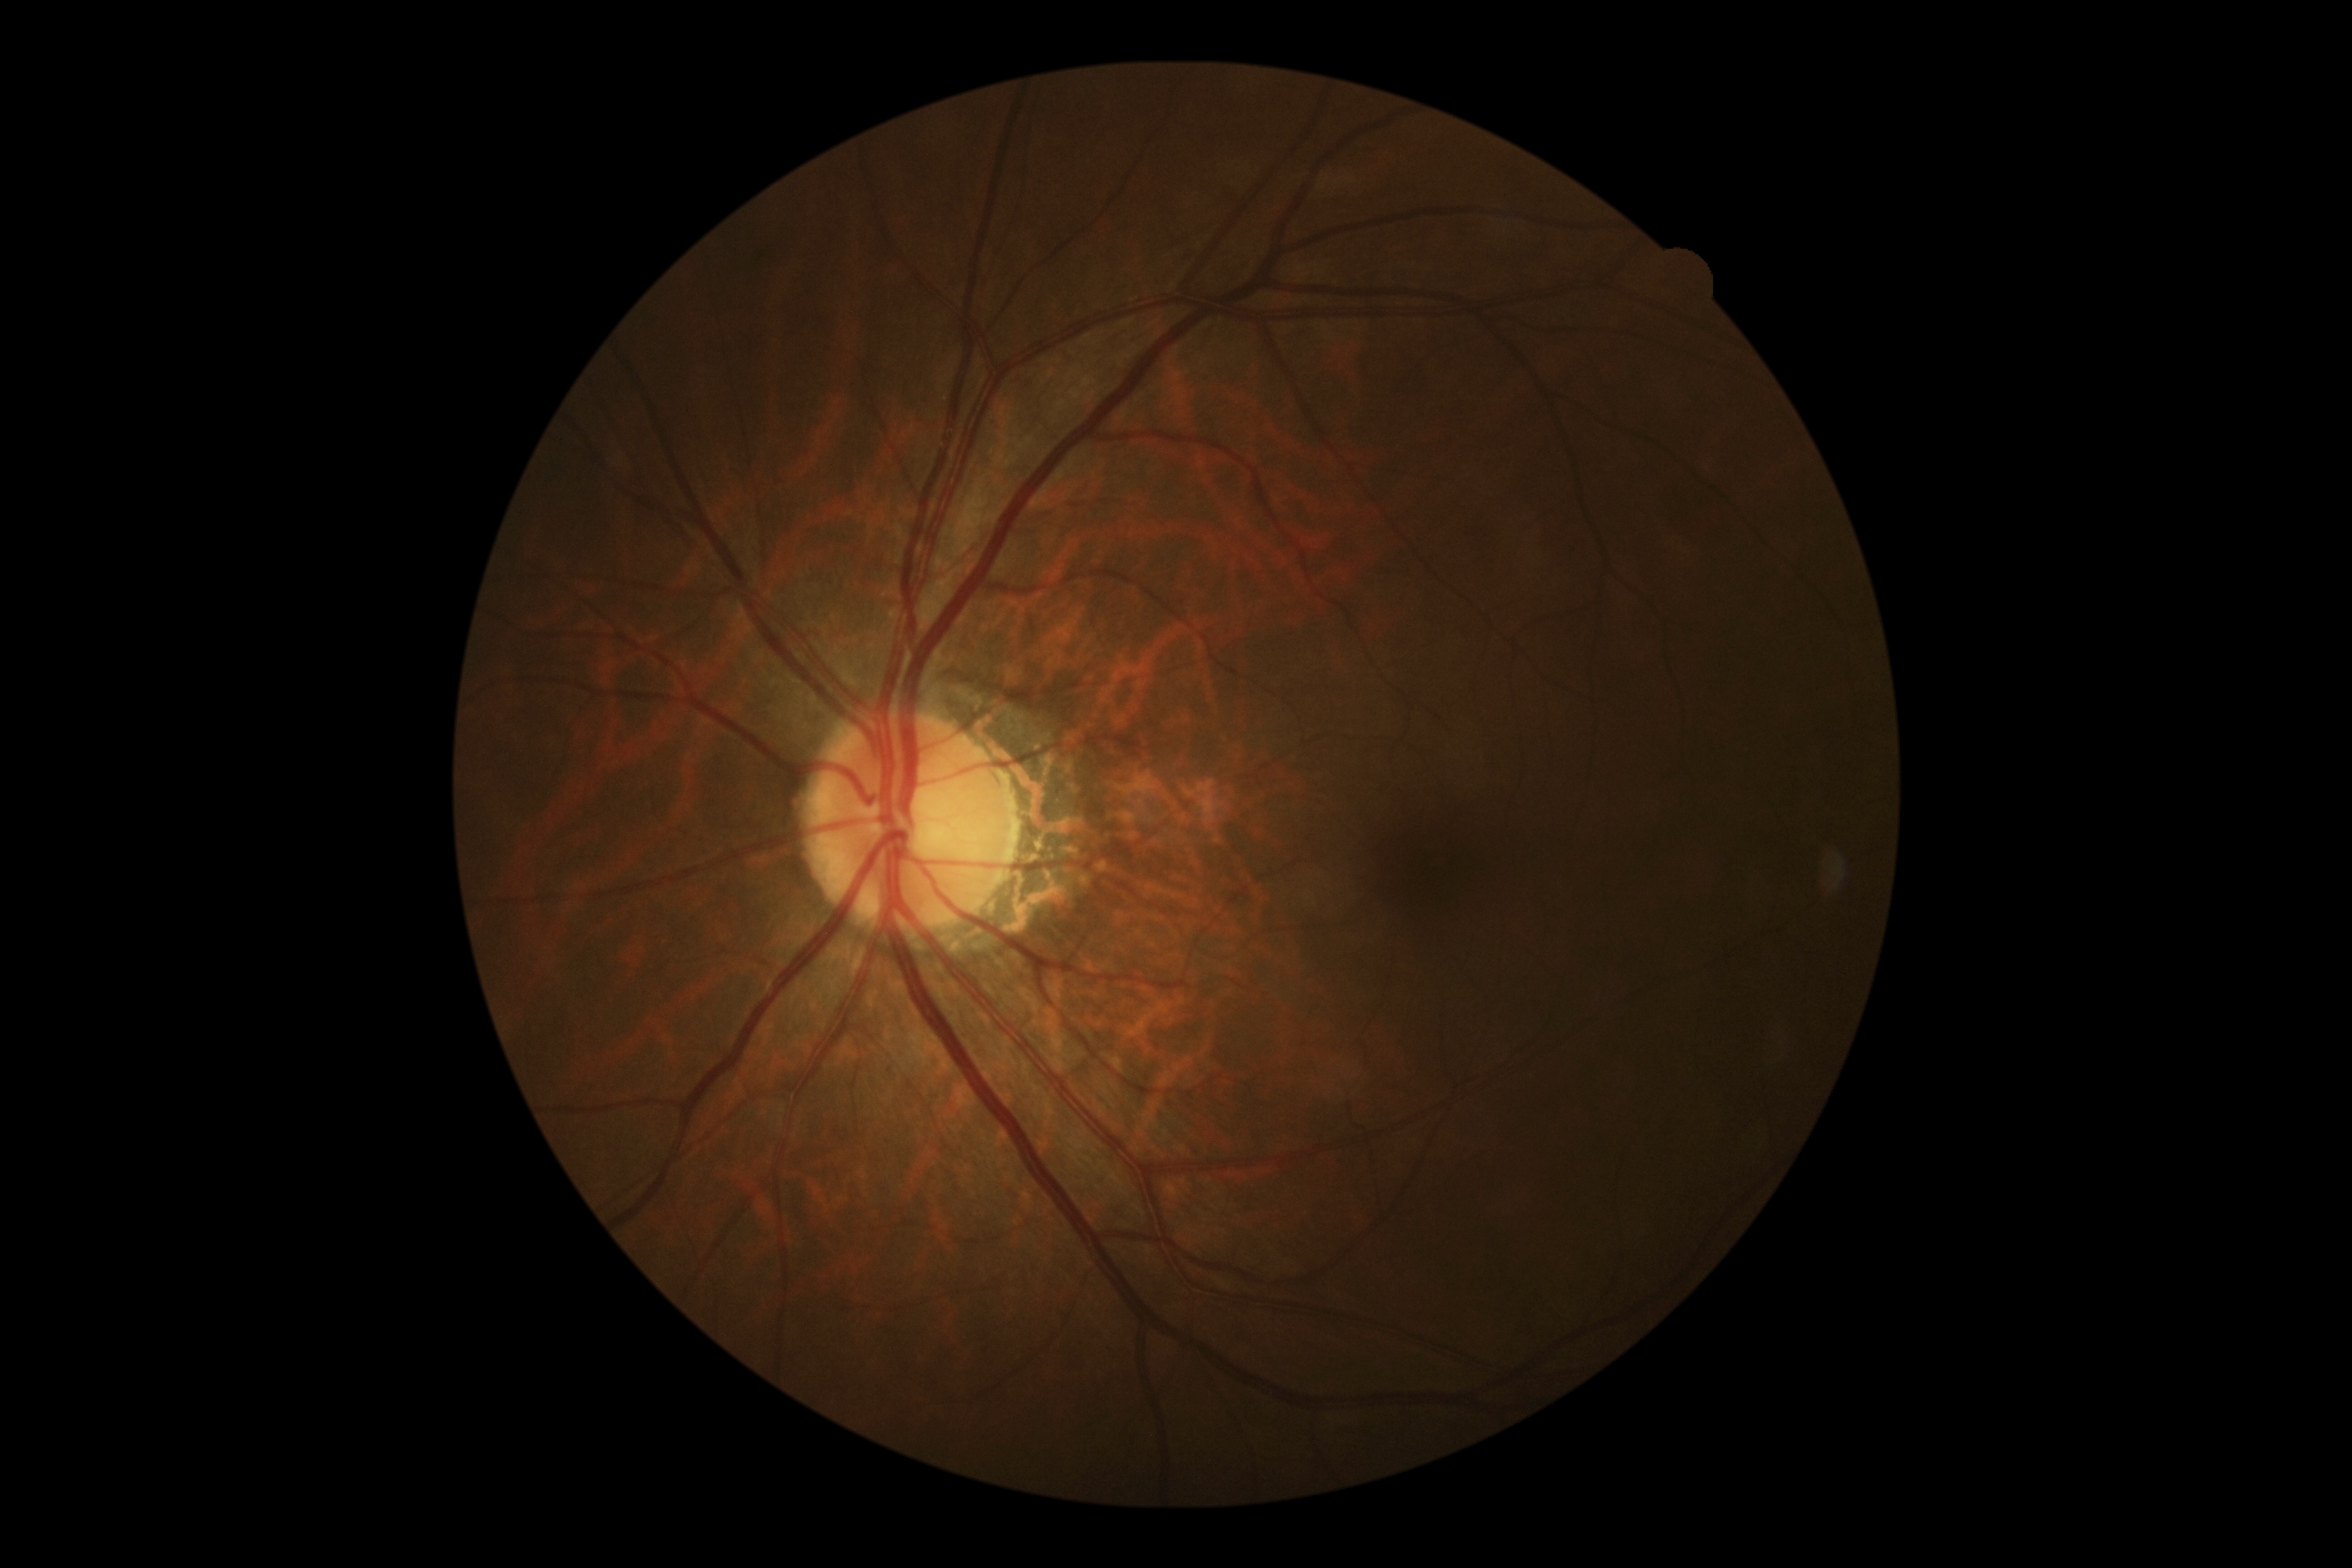 retinopathy@no apparent retinopathy (grade 0).